FOV: 45 degrees. NIDEK AFC-230: 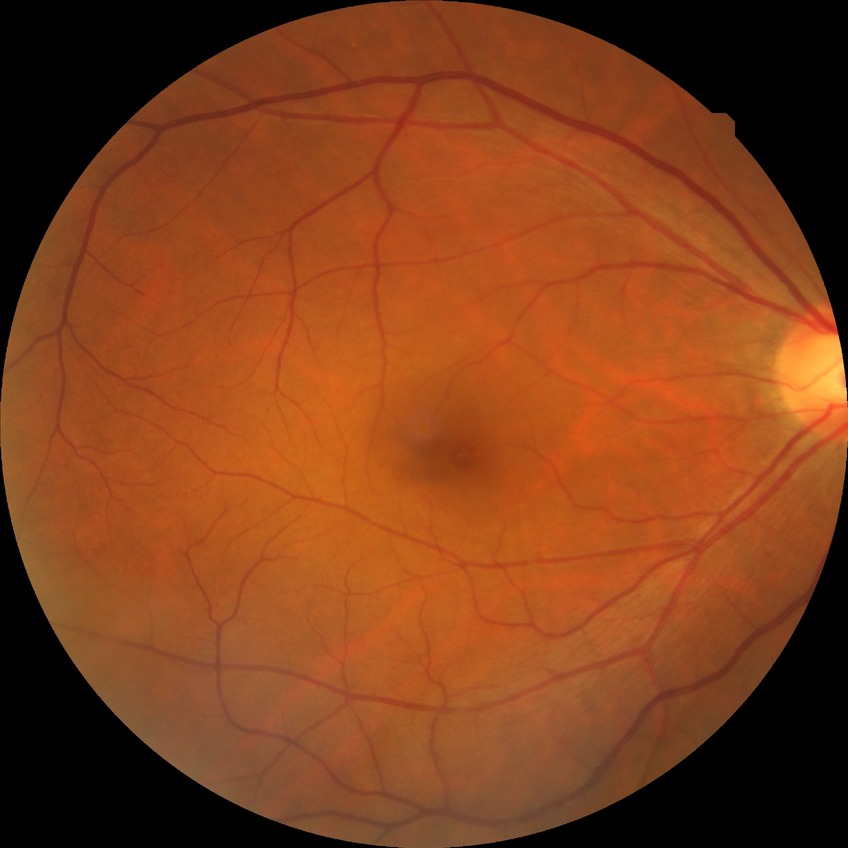 diabetic retinopathy (DR) = no diabetic retinopathy (NDR).